Camera: Clarity RetCam 3 (130° FOV); wide-field fundus image from infant ROP screening — 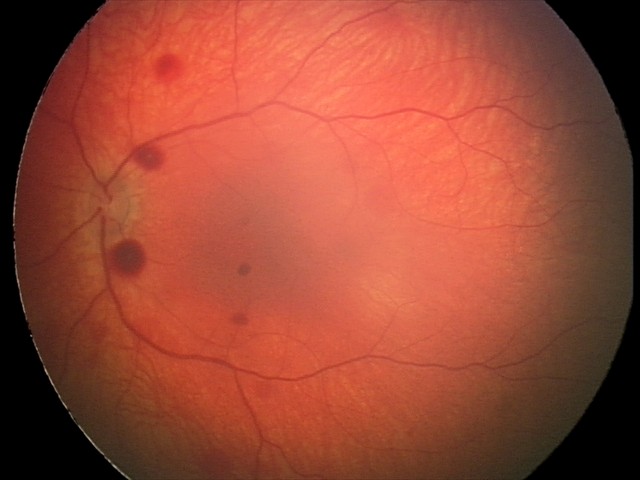

Diagnosis from this screening exam: retinal hemorrhages.